2212 by 1659 pixels
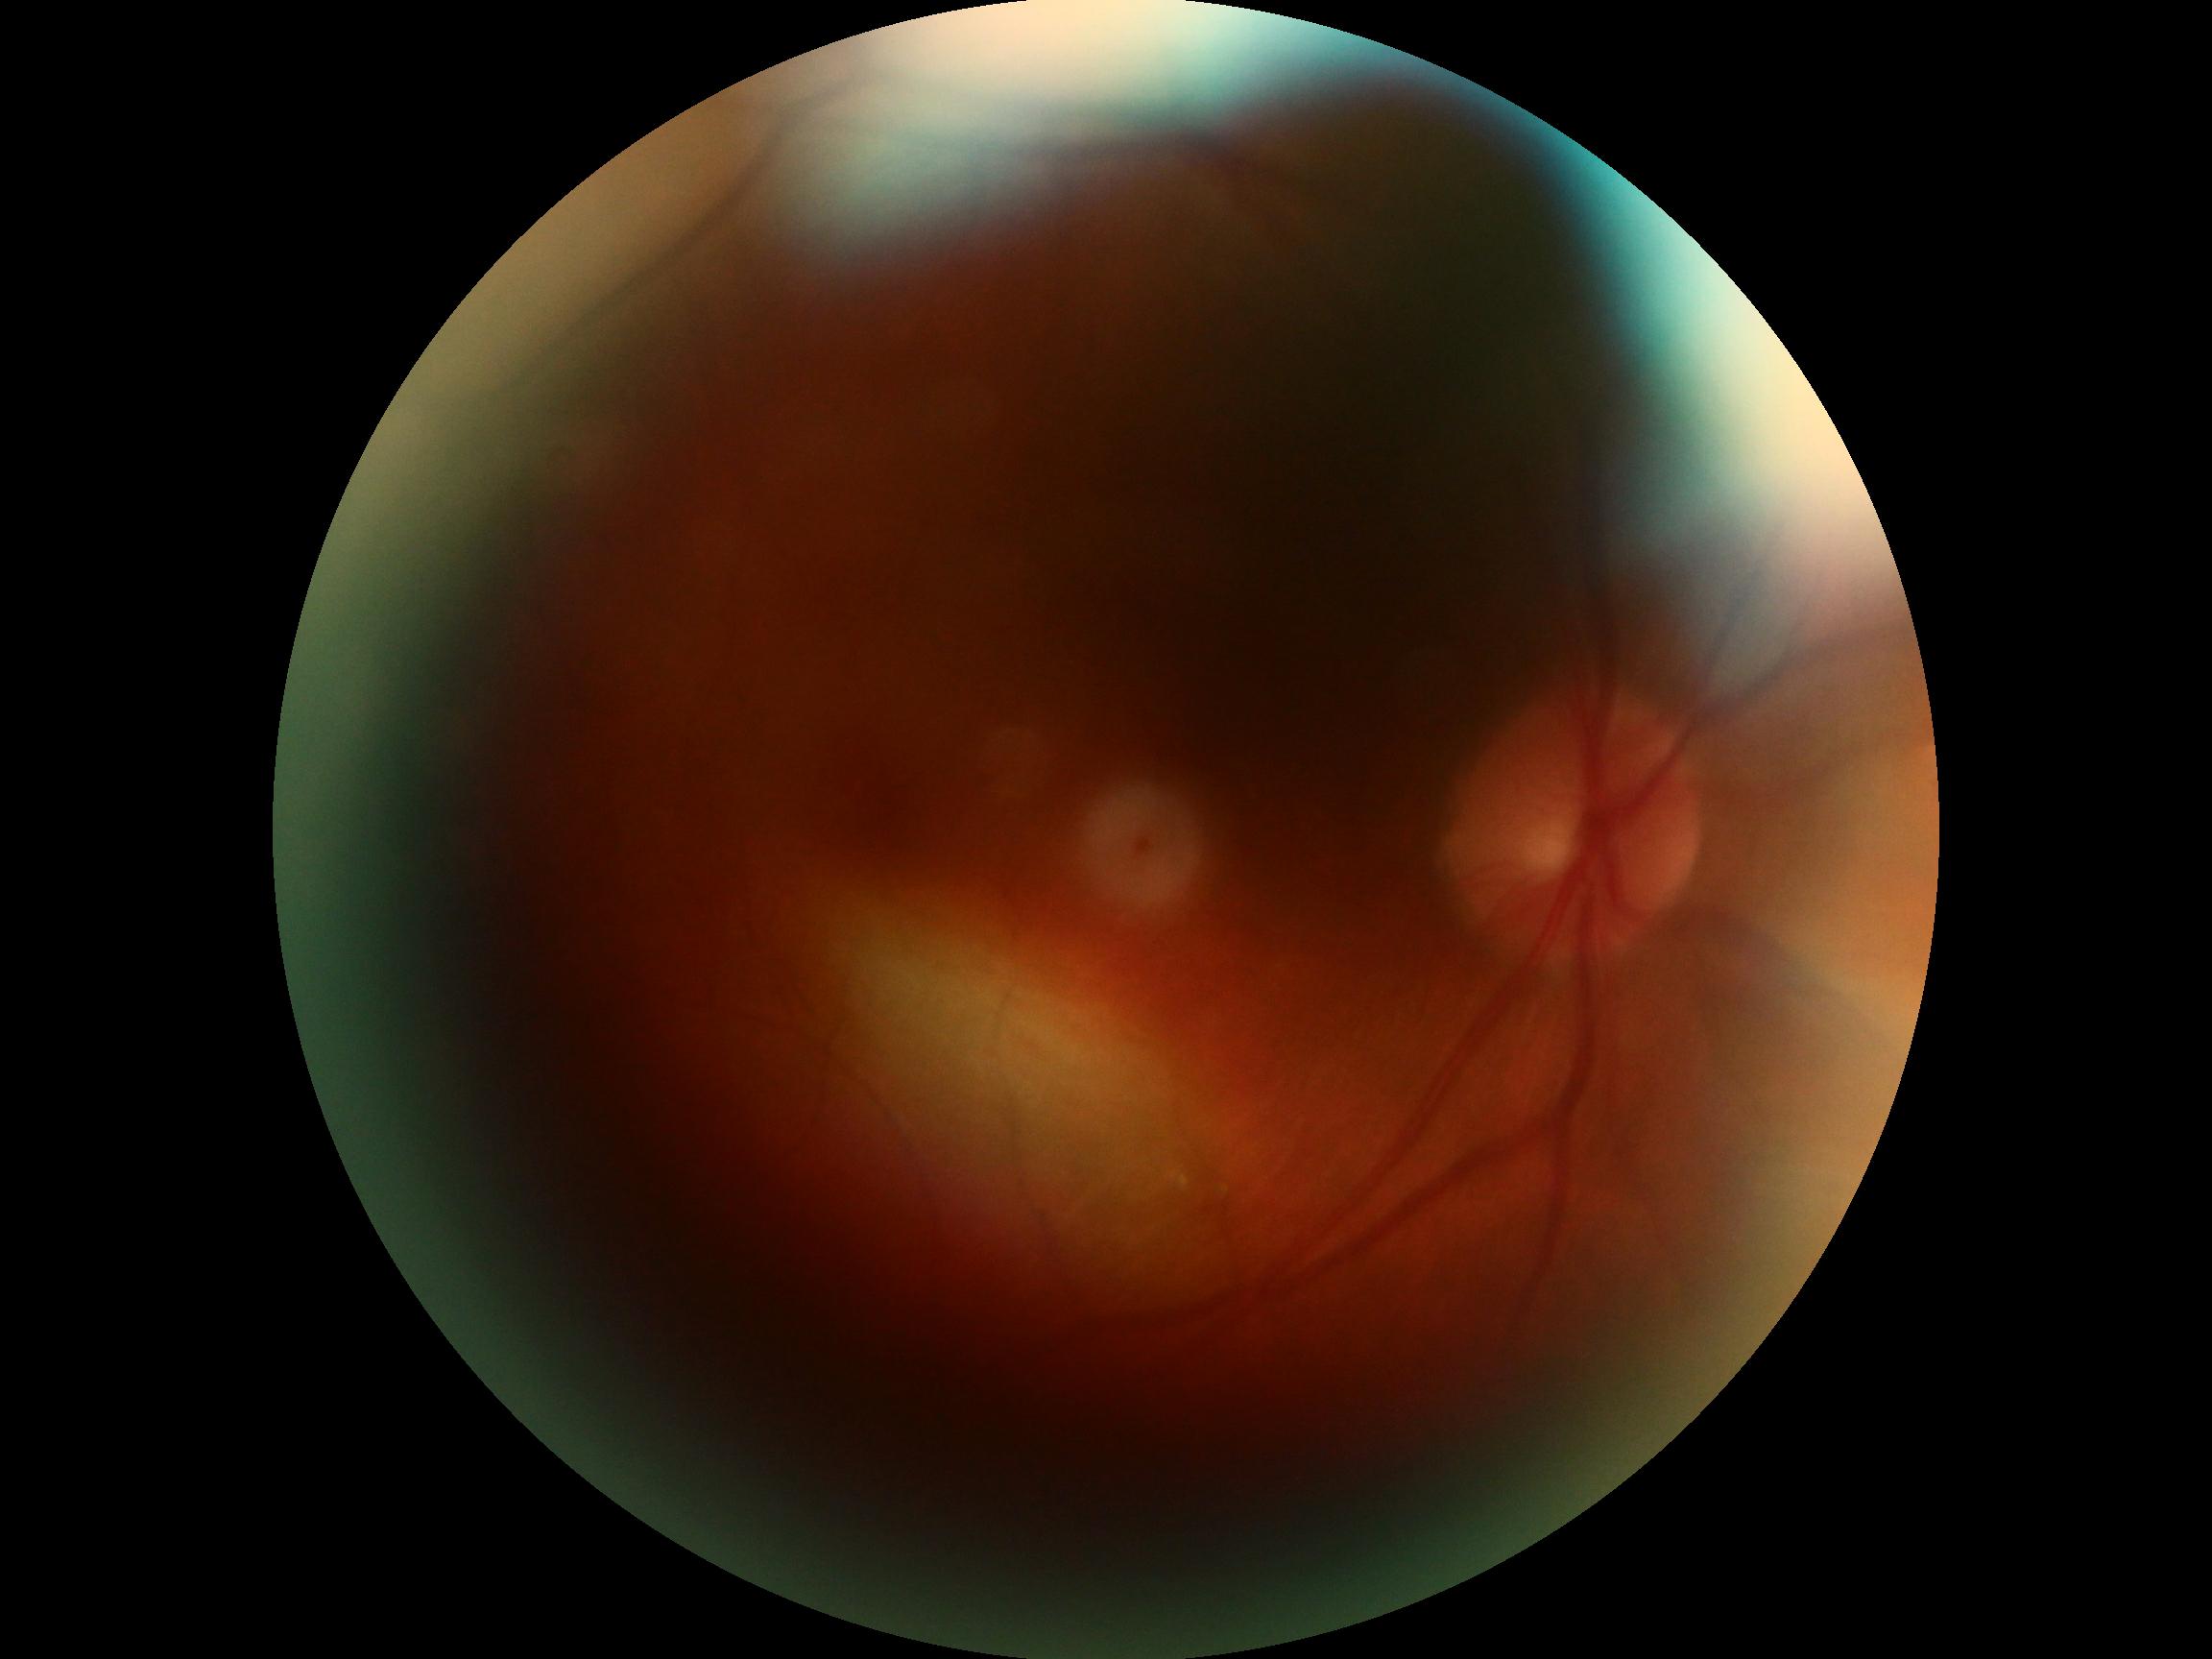
Ungradable image — DR severity cannot be determined. DR grade is ungradable due to poor image quality.